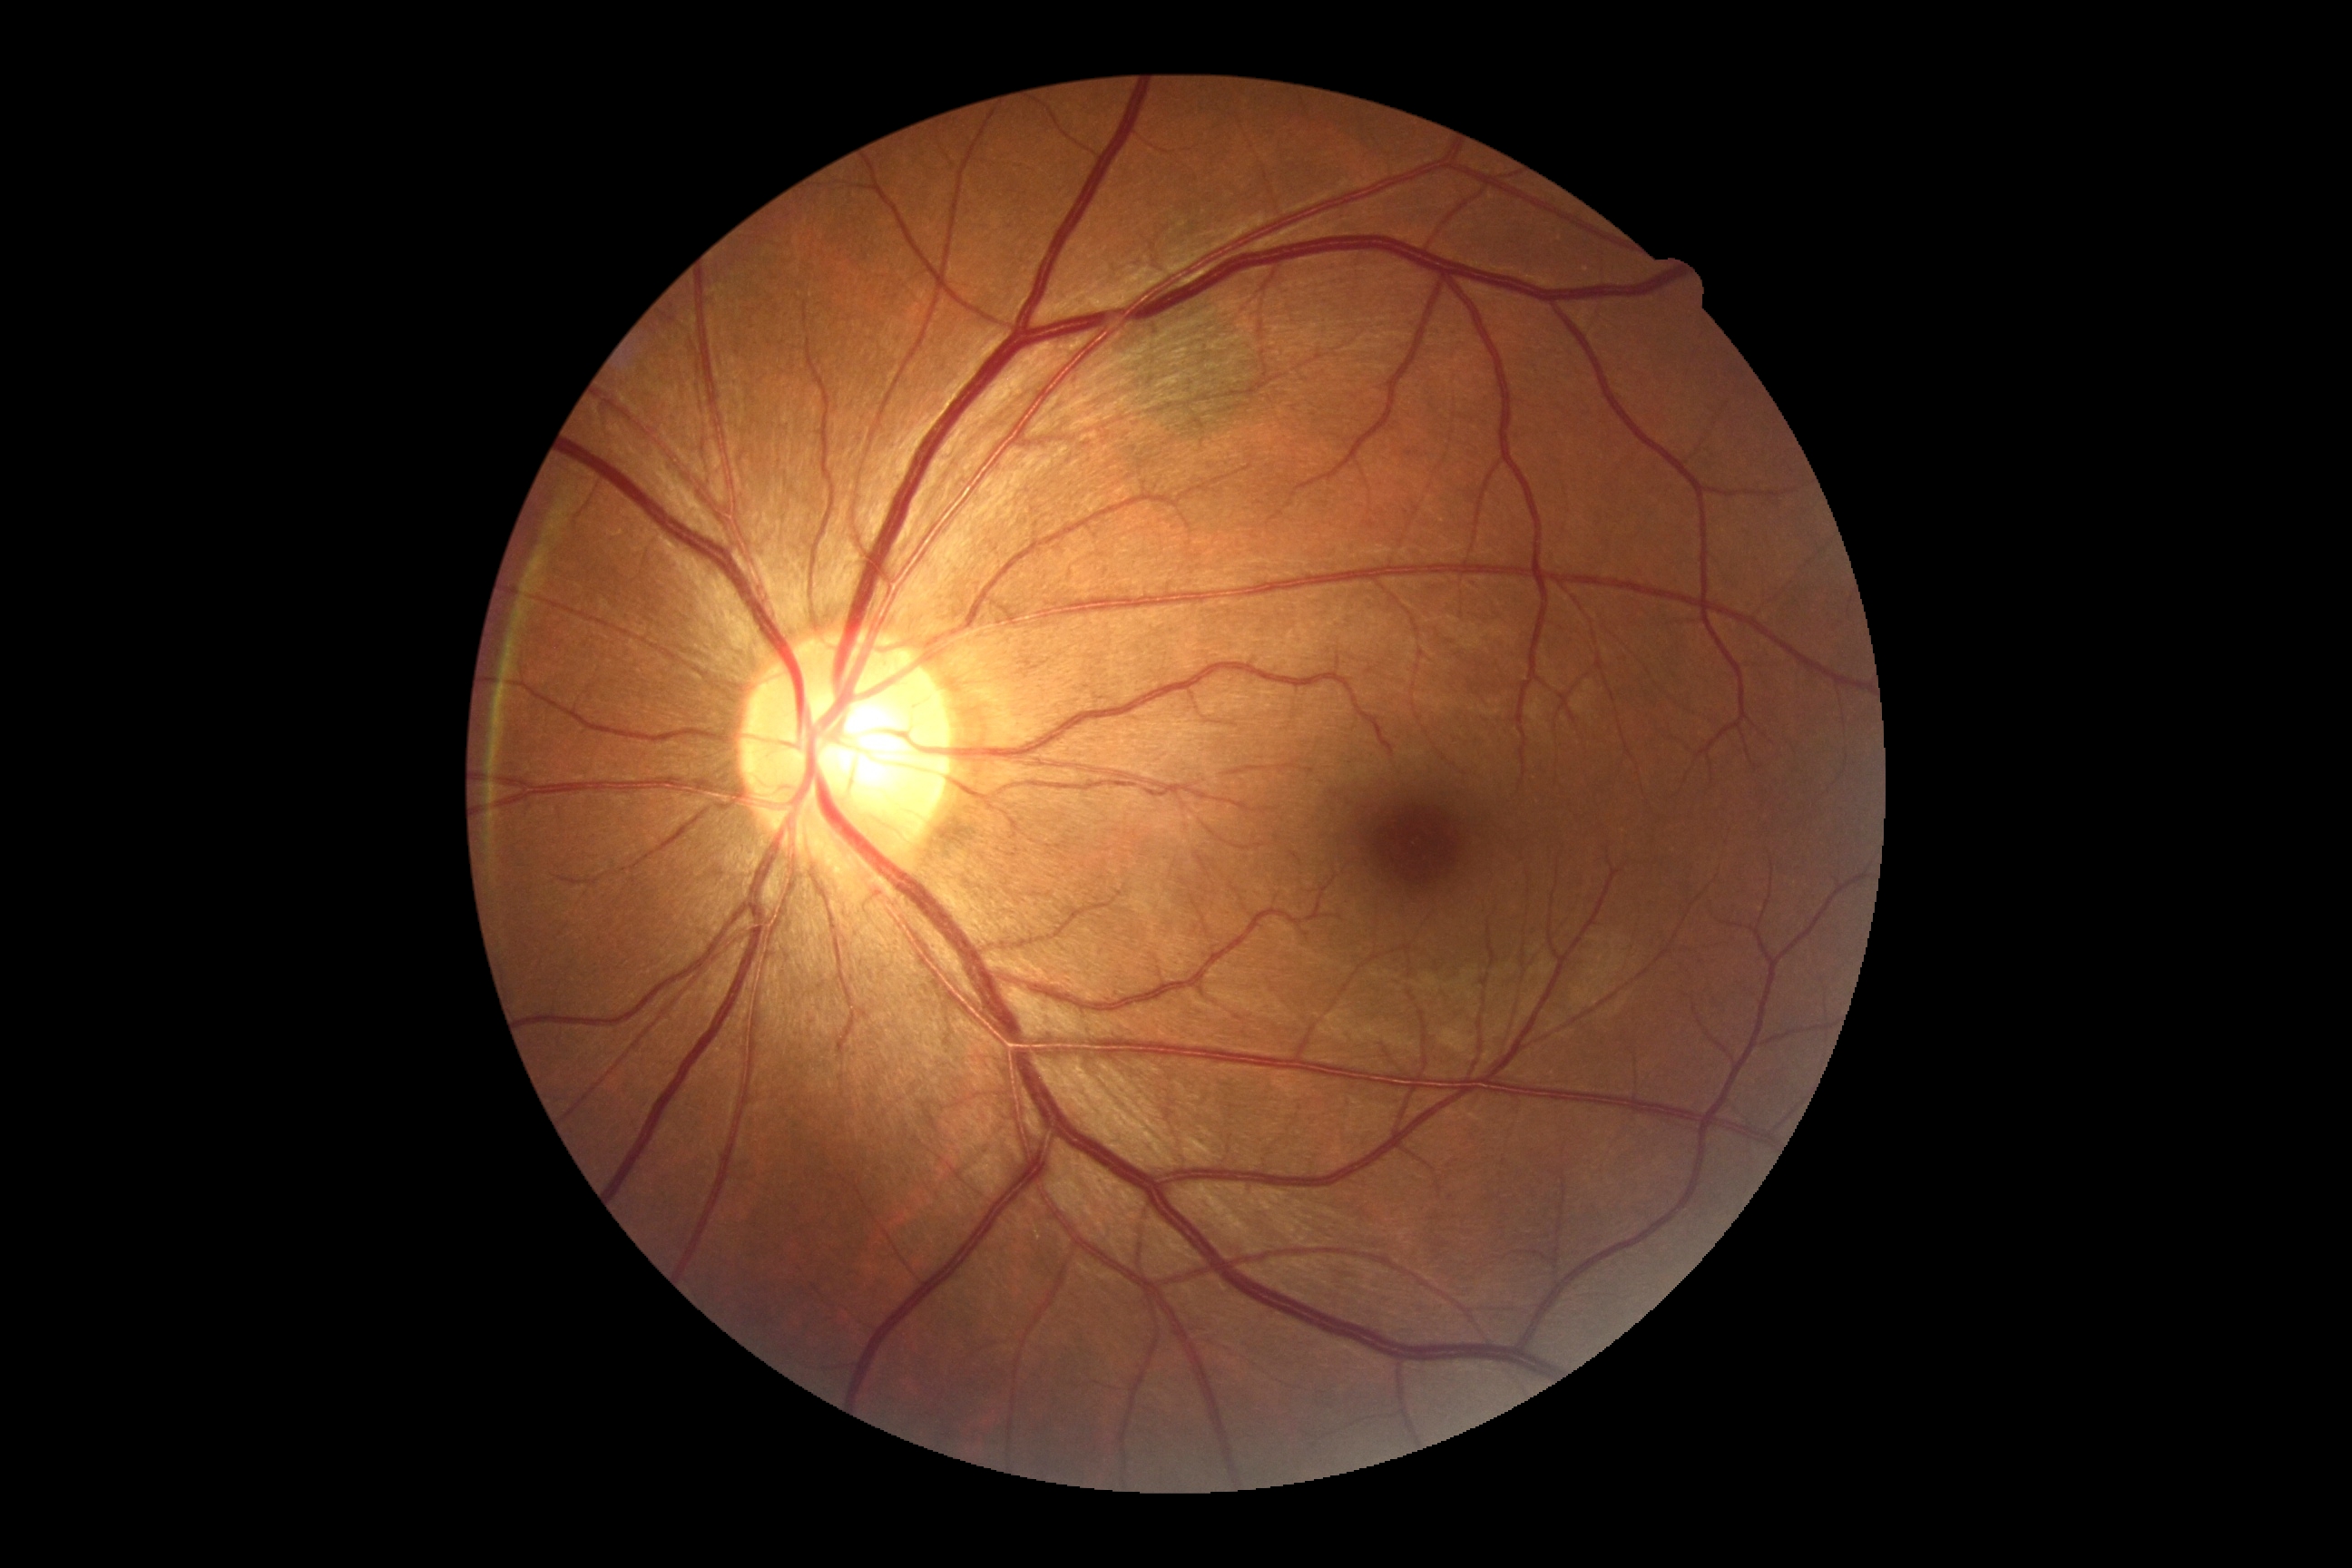

Annotations:
* DR grade — 0 — no visible signs of diabetic retinopathy